Ultra-widefield fundus photograph; 1924 x 1556 pixels; 200° FOV: 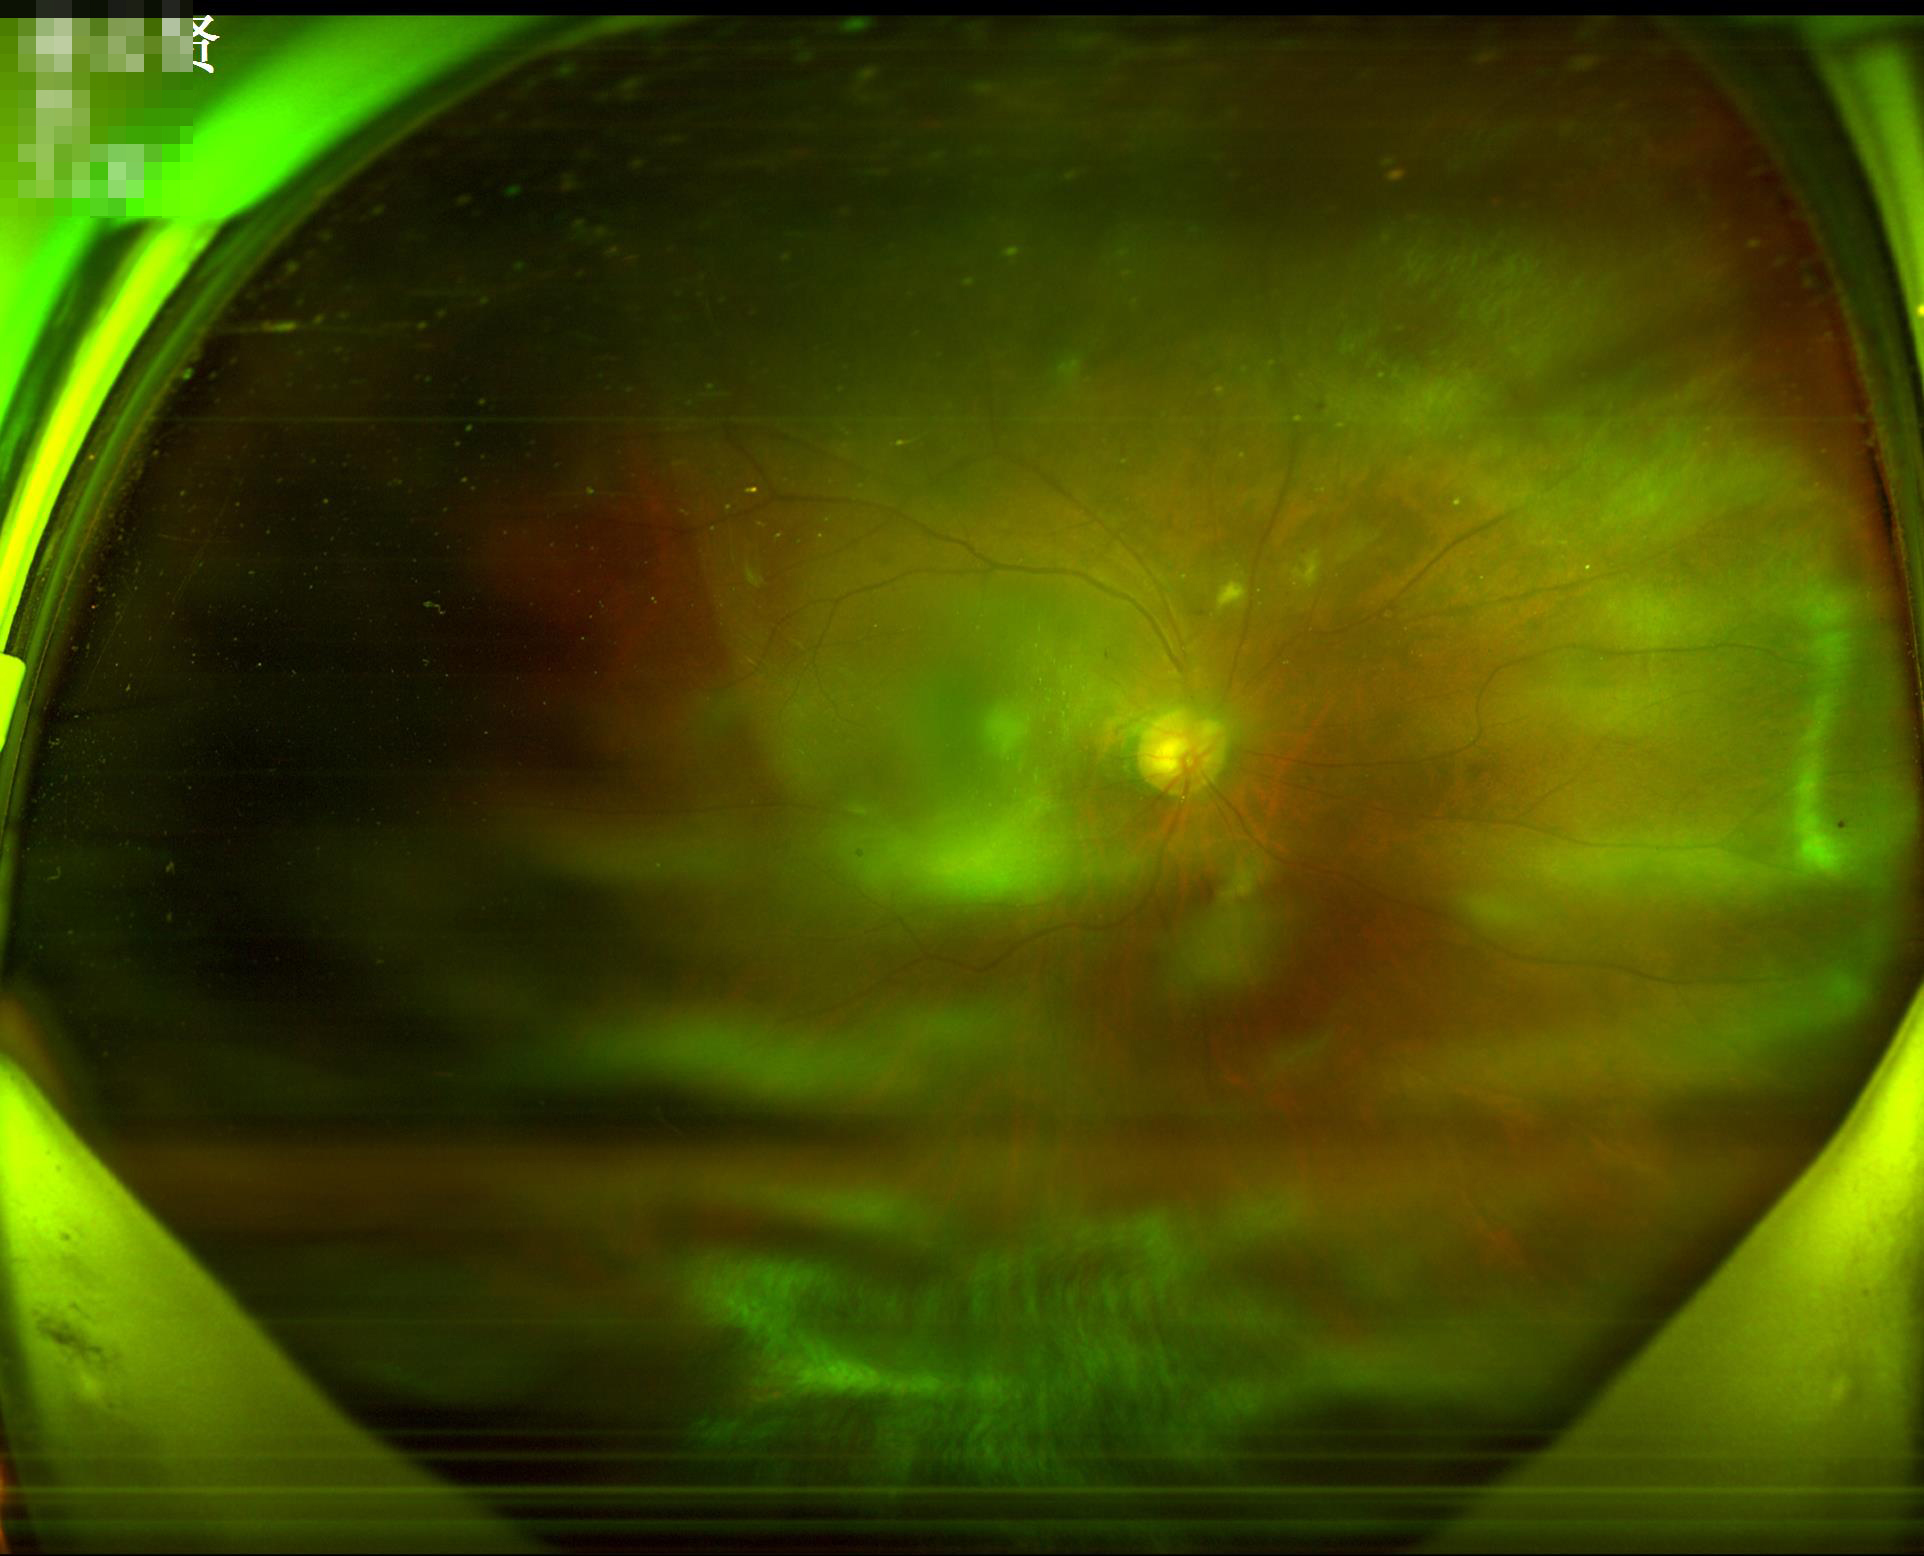 Out of focus; structures are indistinct. Image quality is inadequate for diagnostic use. Good dynamic range.